Modified Davis grading; 848x848; retinal fundus photograph — 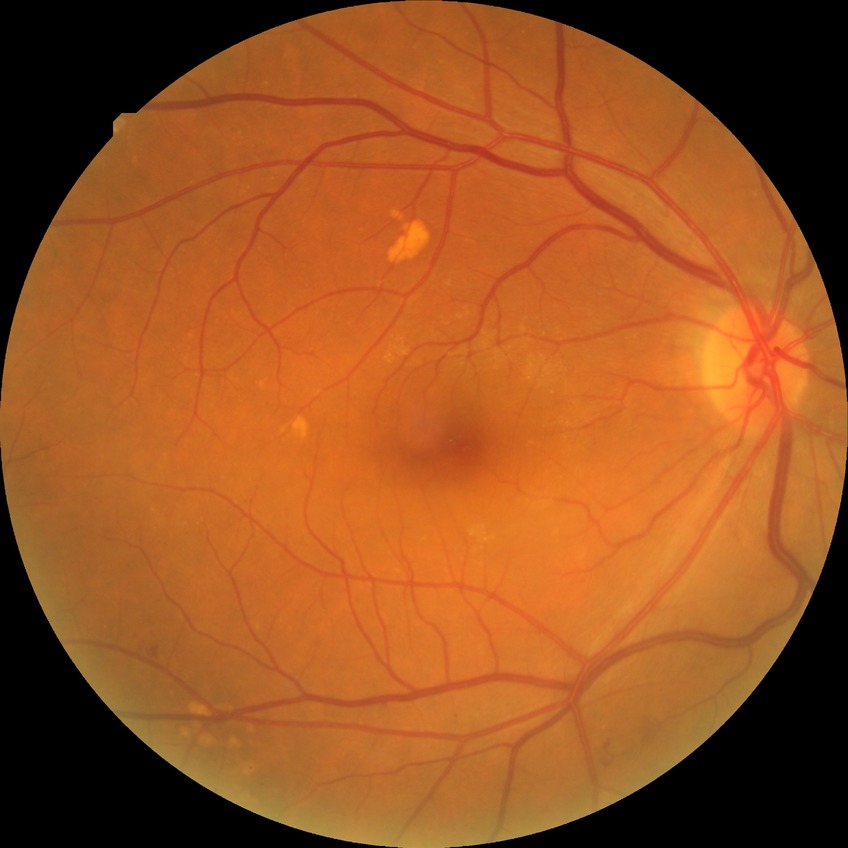 Davis grading: simple diabetic retinopathy.